2352x1568px: 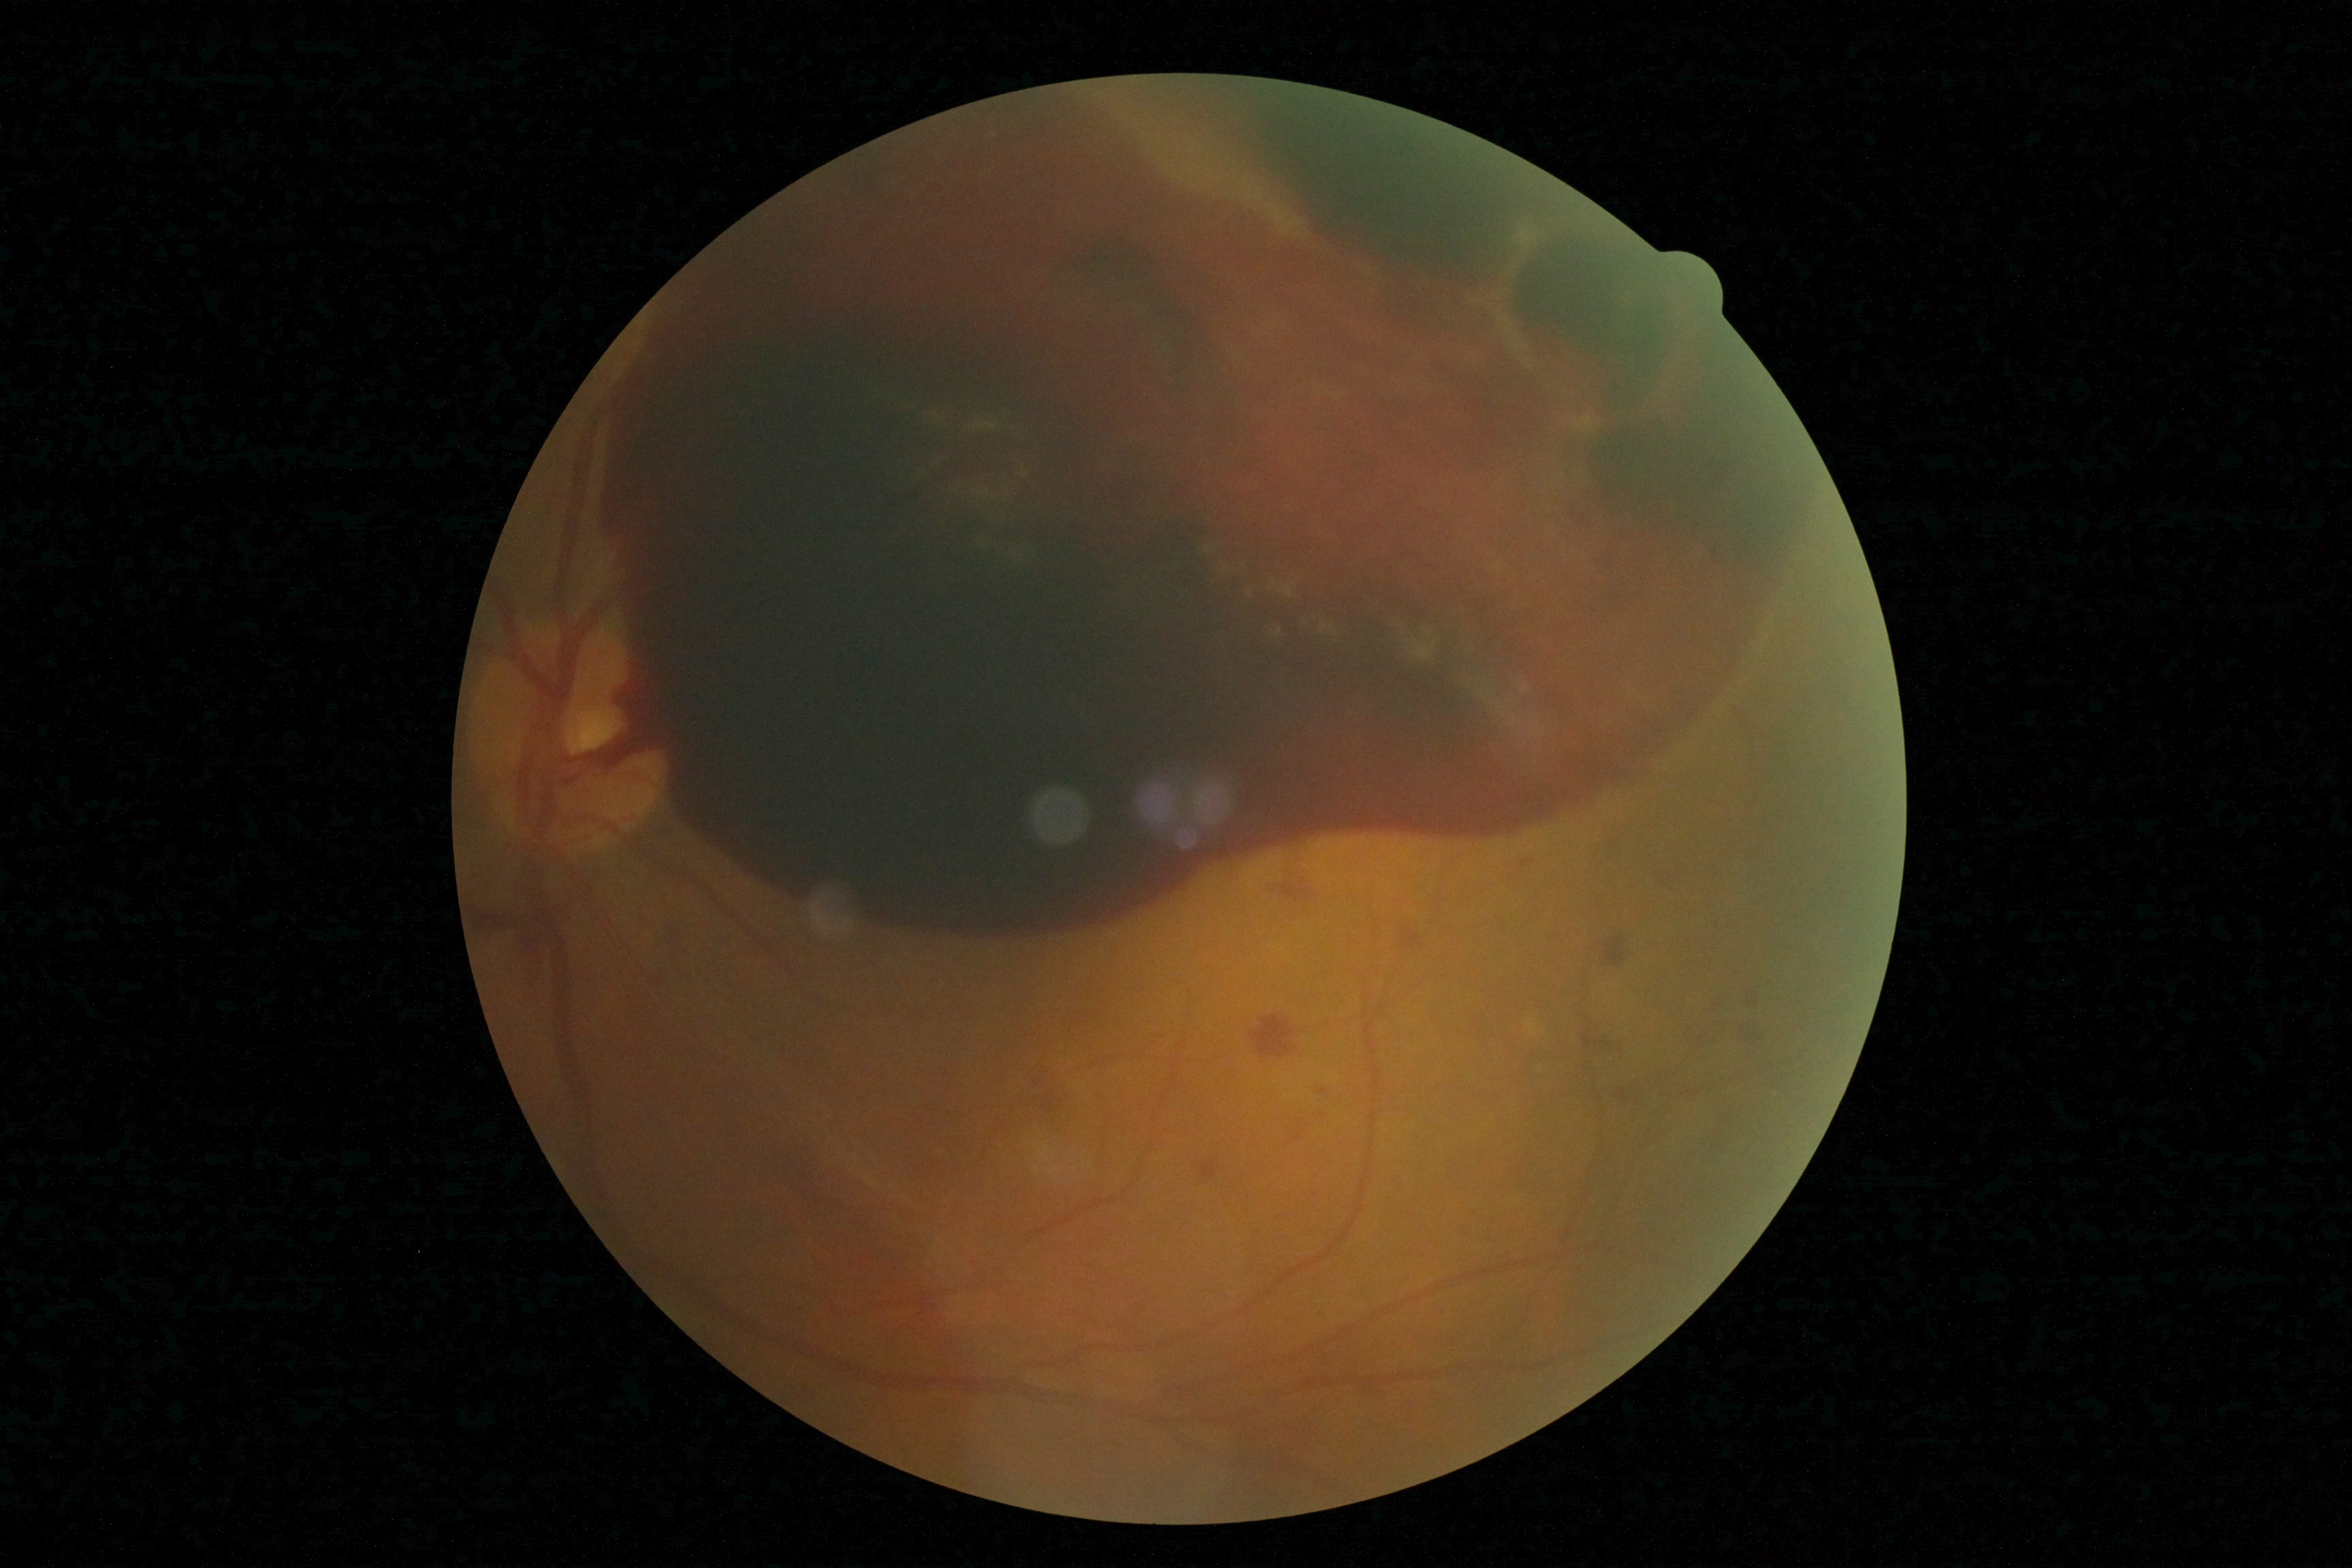
DR stage is grade 4 (PDR).